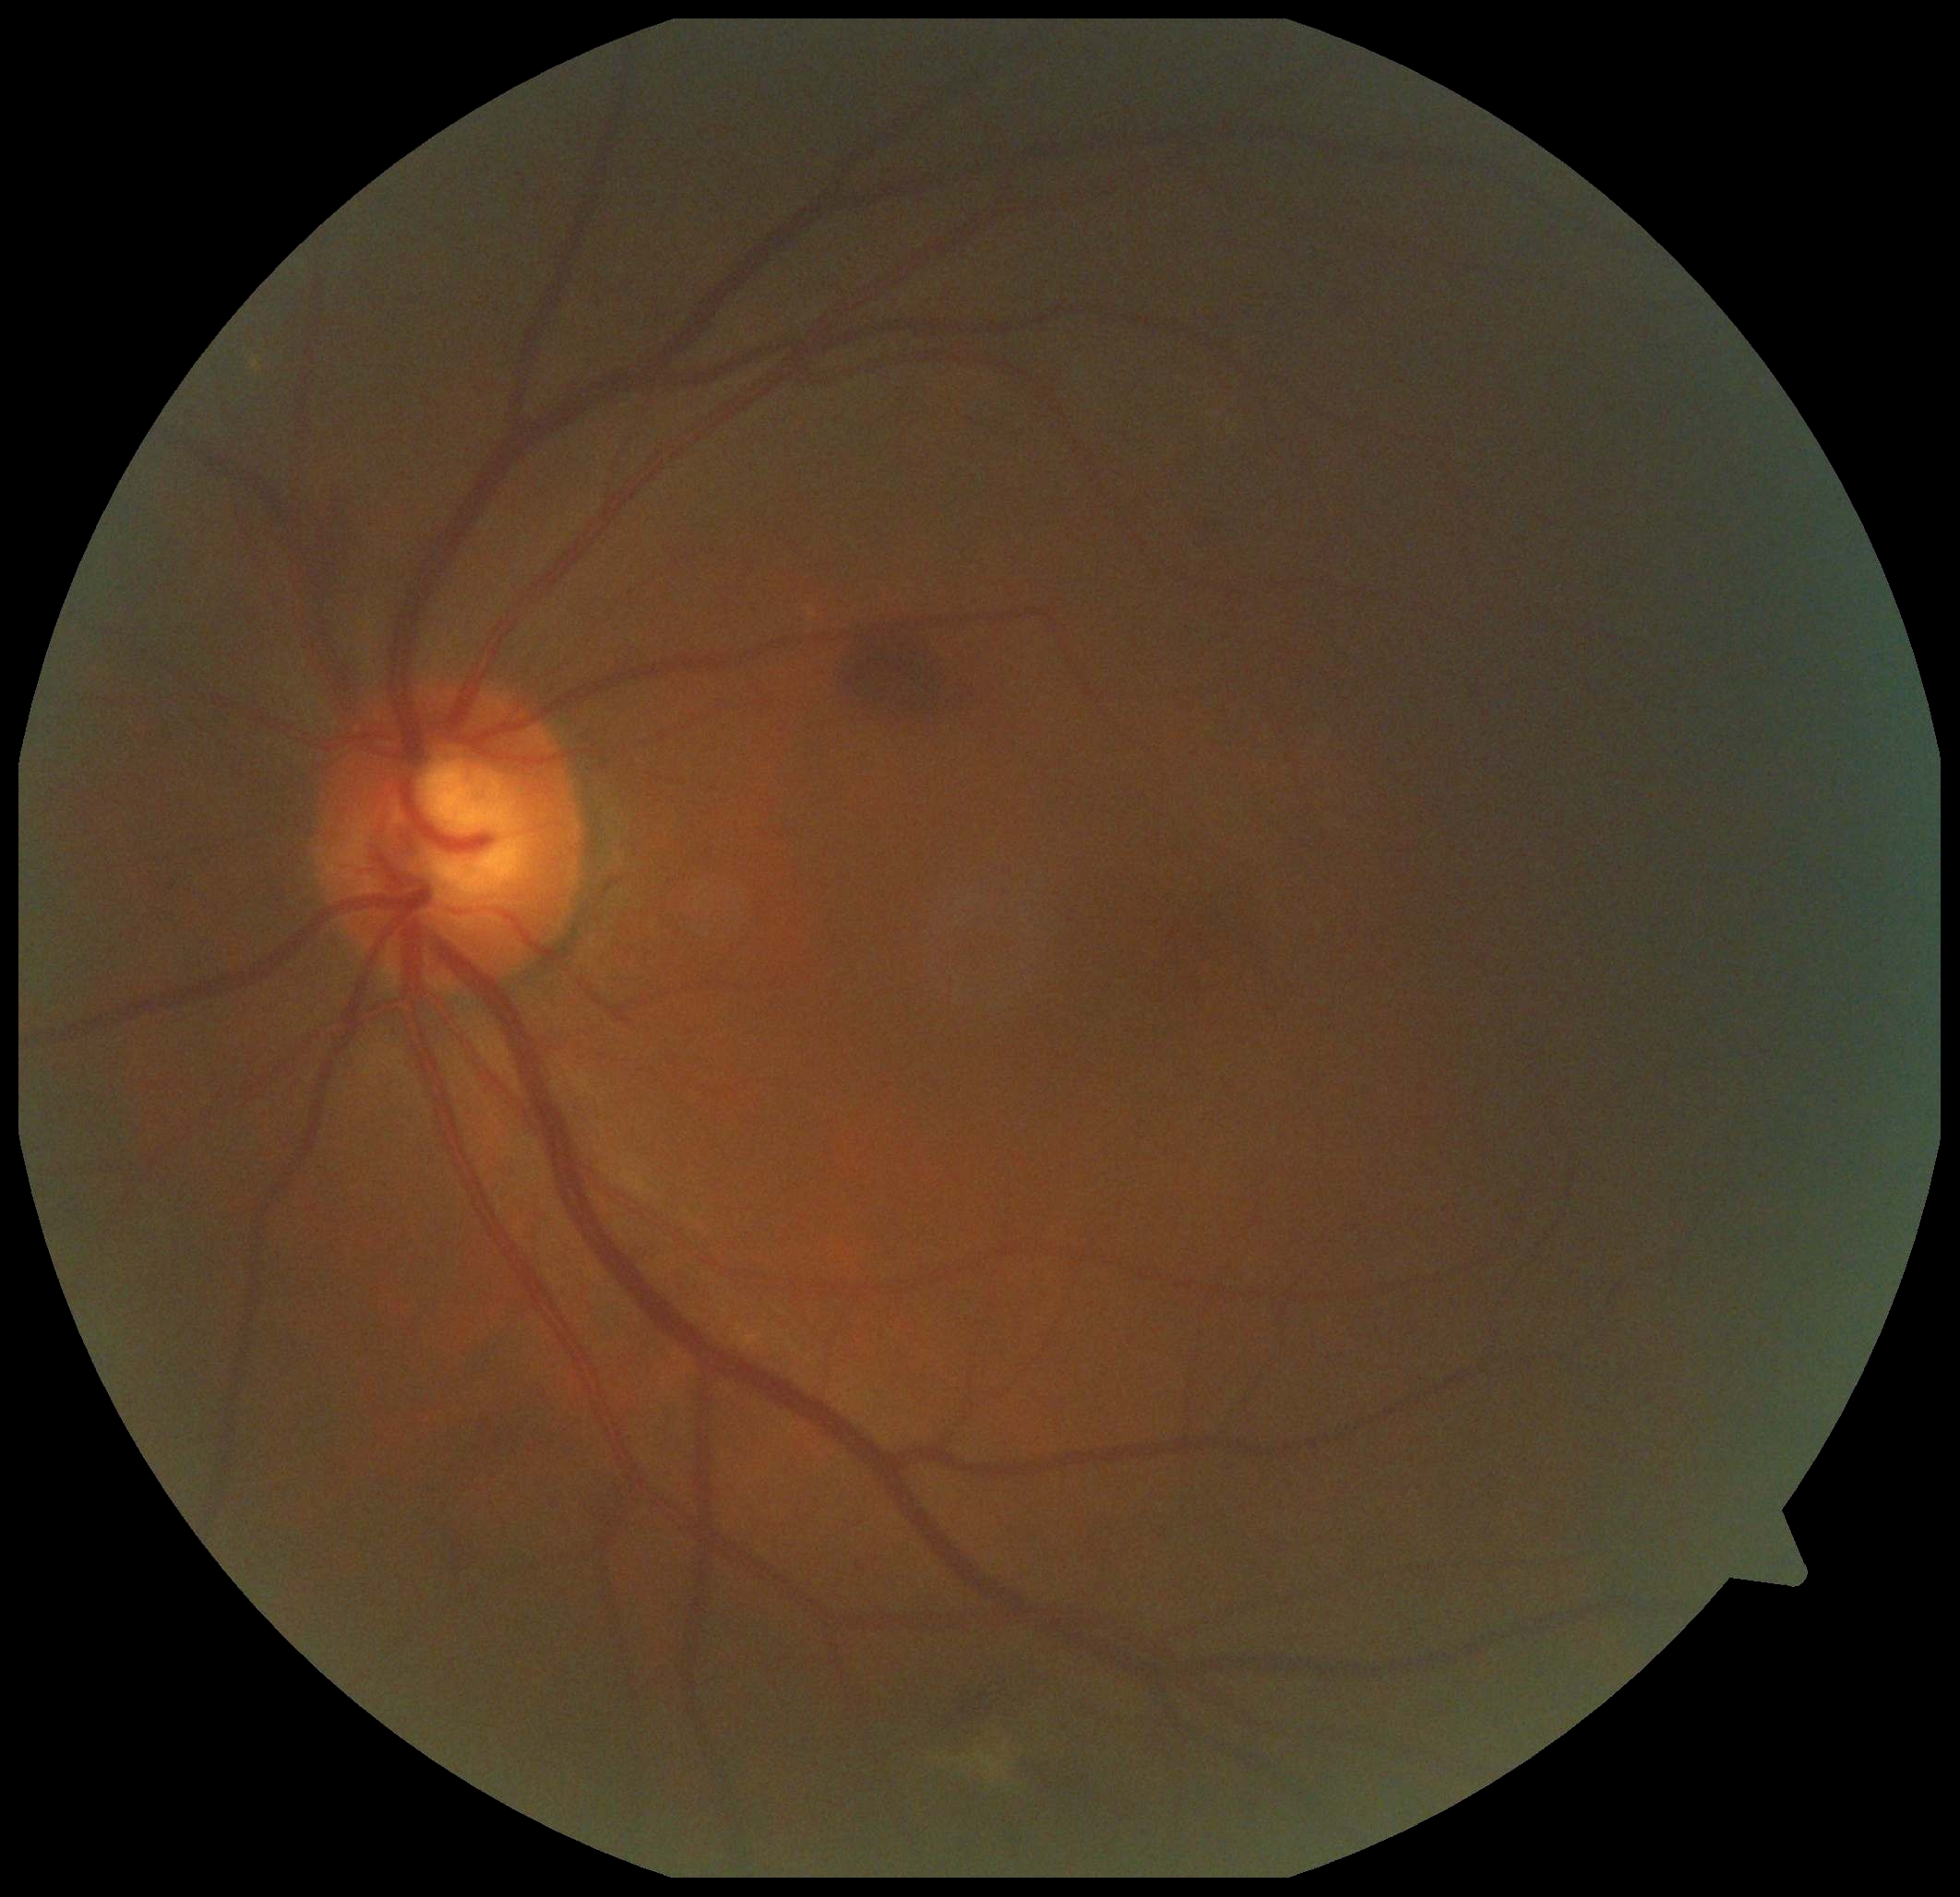

diabetic retinopathy (DR): 2/4.